45° field of view, retinal fundus photograph, image size 2212x1659: 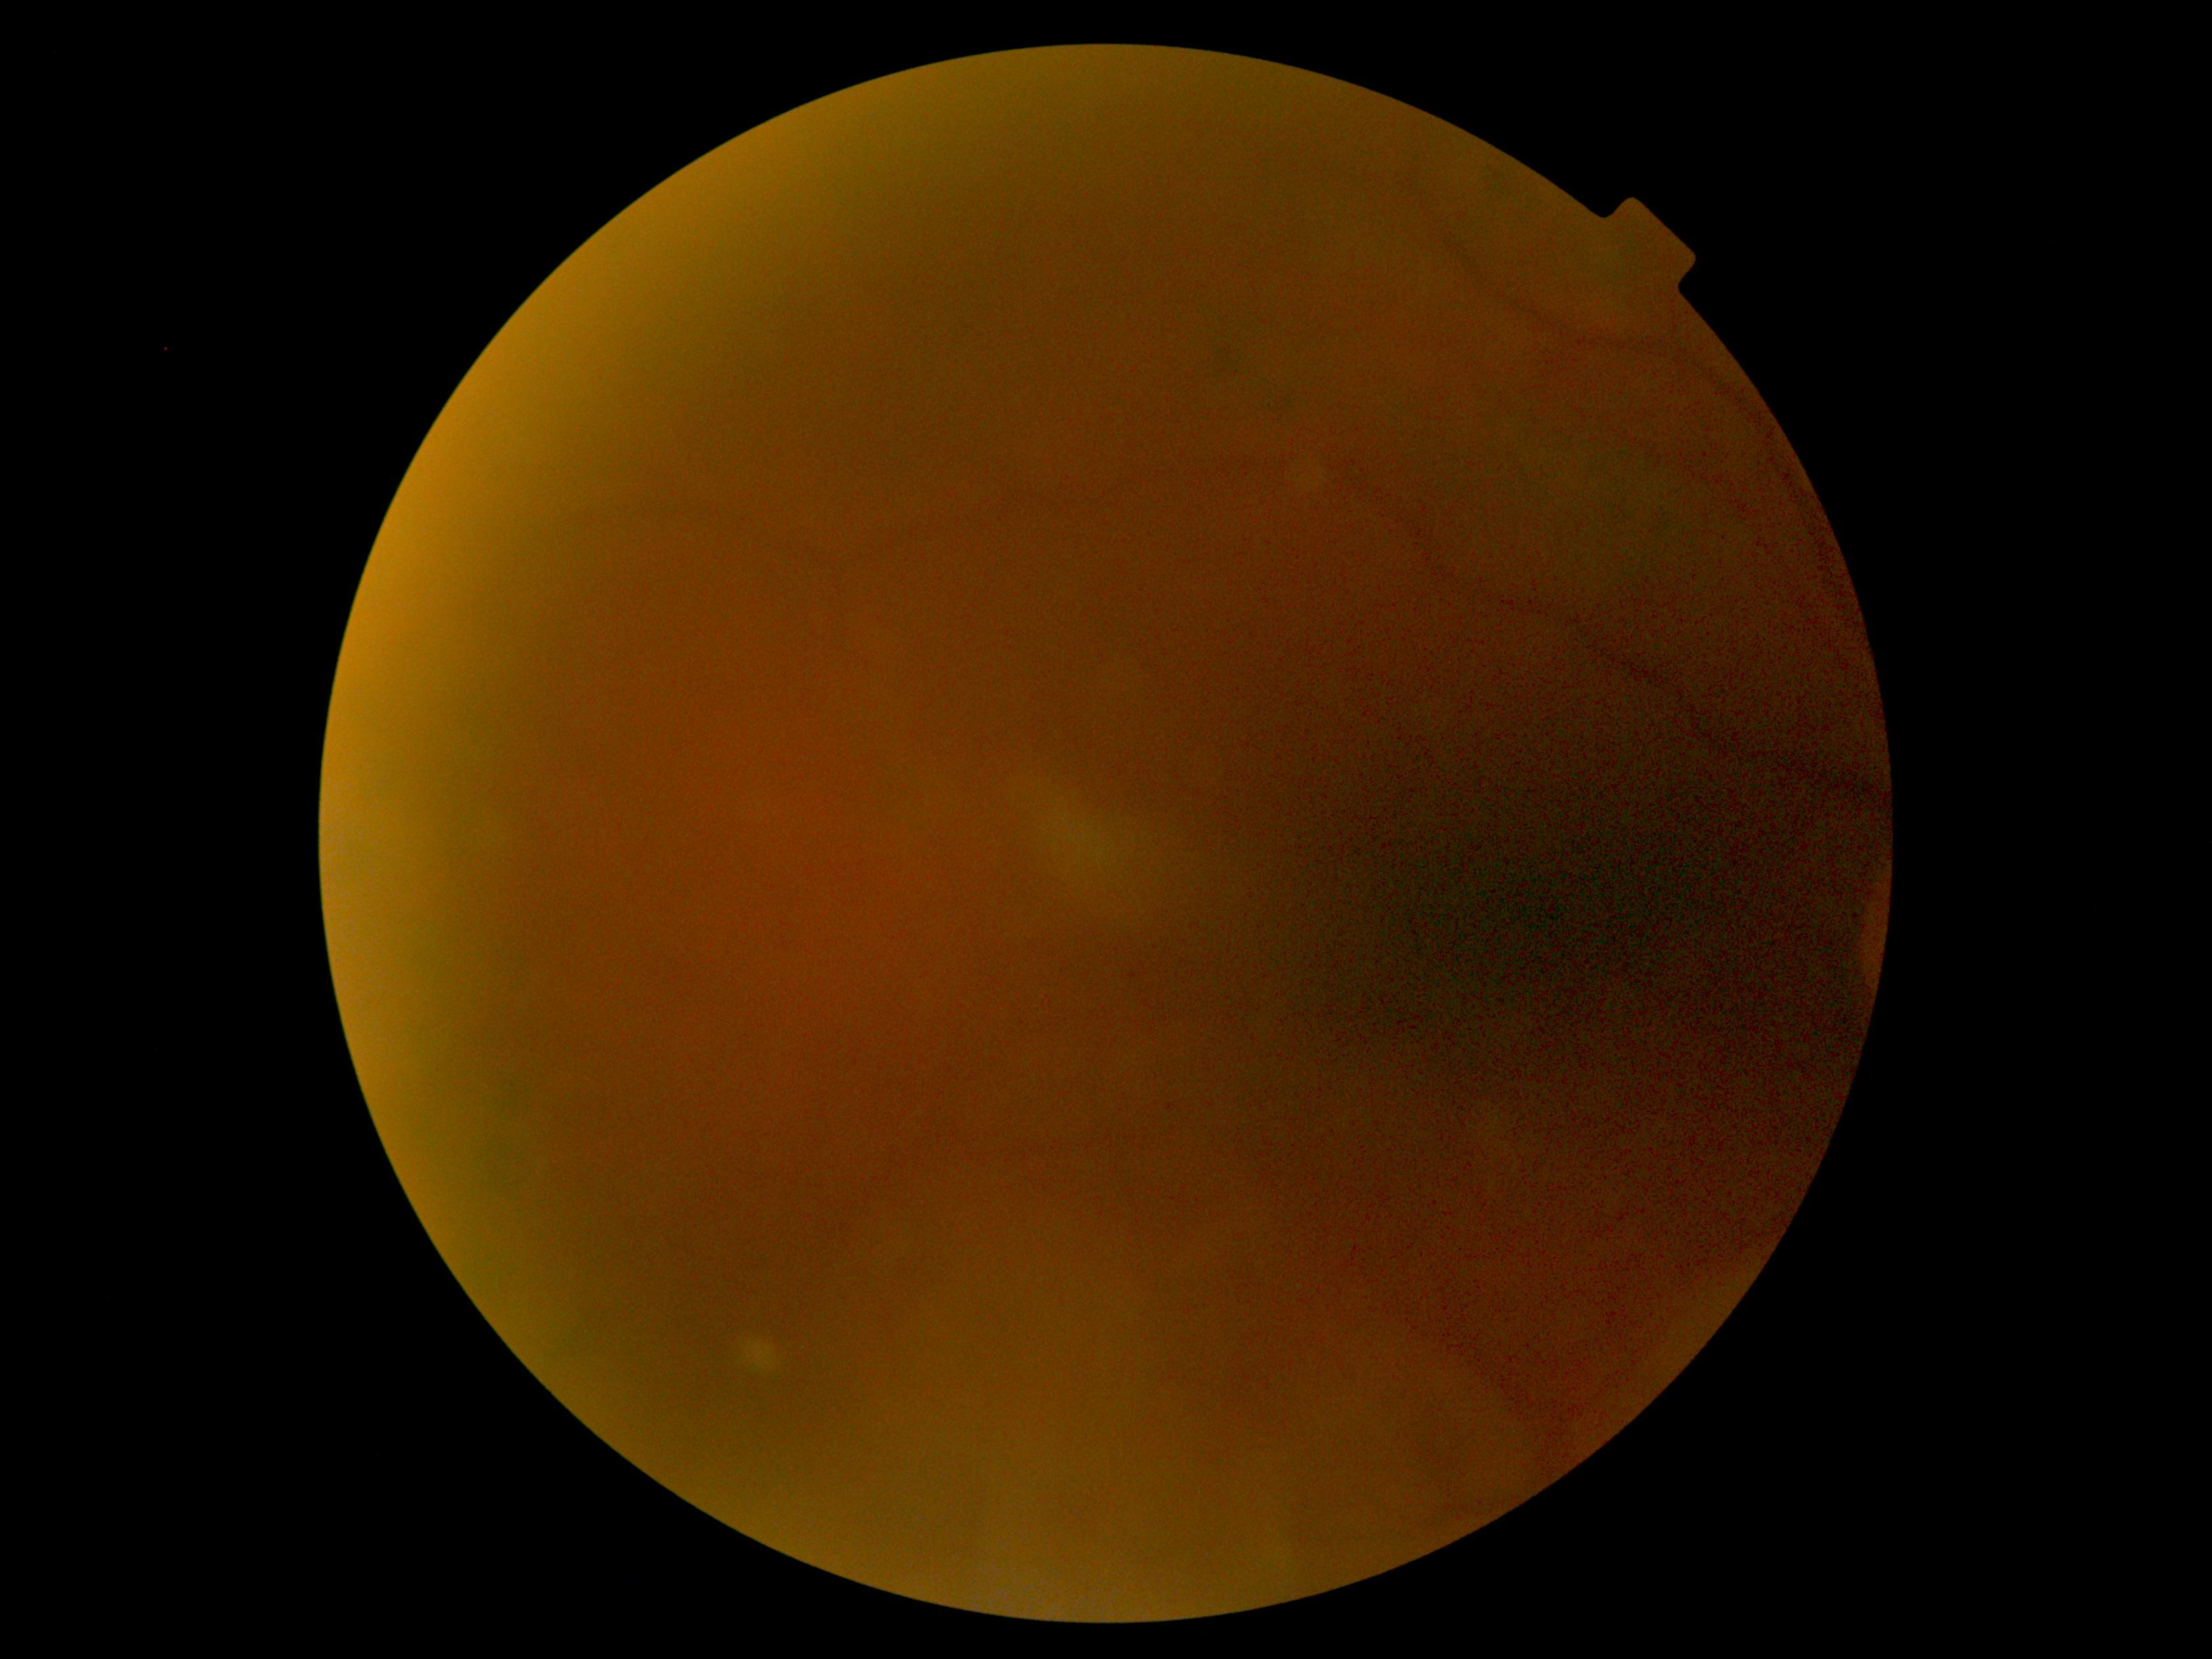

Retinopathy is ungradable.
Quality too poor to assess for DR.